Wide-field fundus photograph from neonatal ROP screening · 1440x1080px · Natus RetCam Envision, 130° FOV — 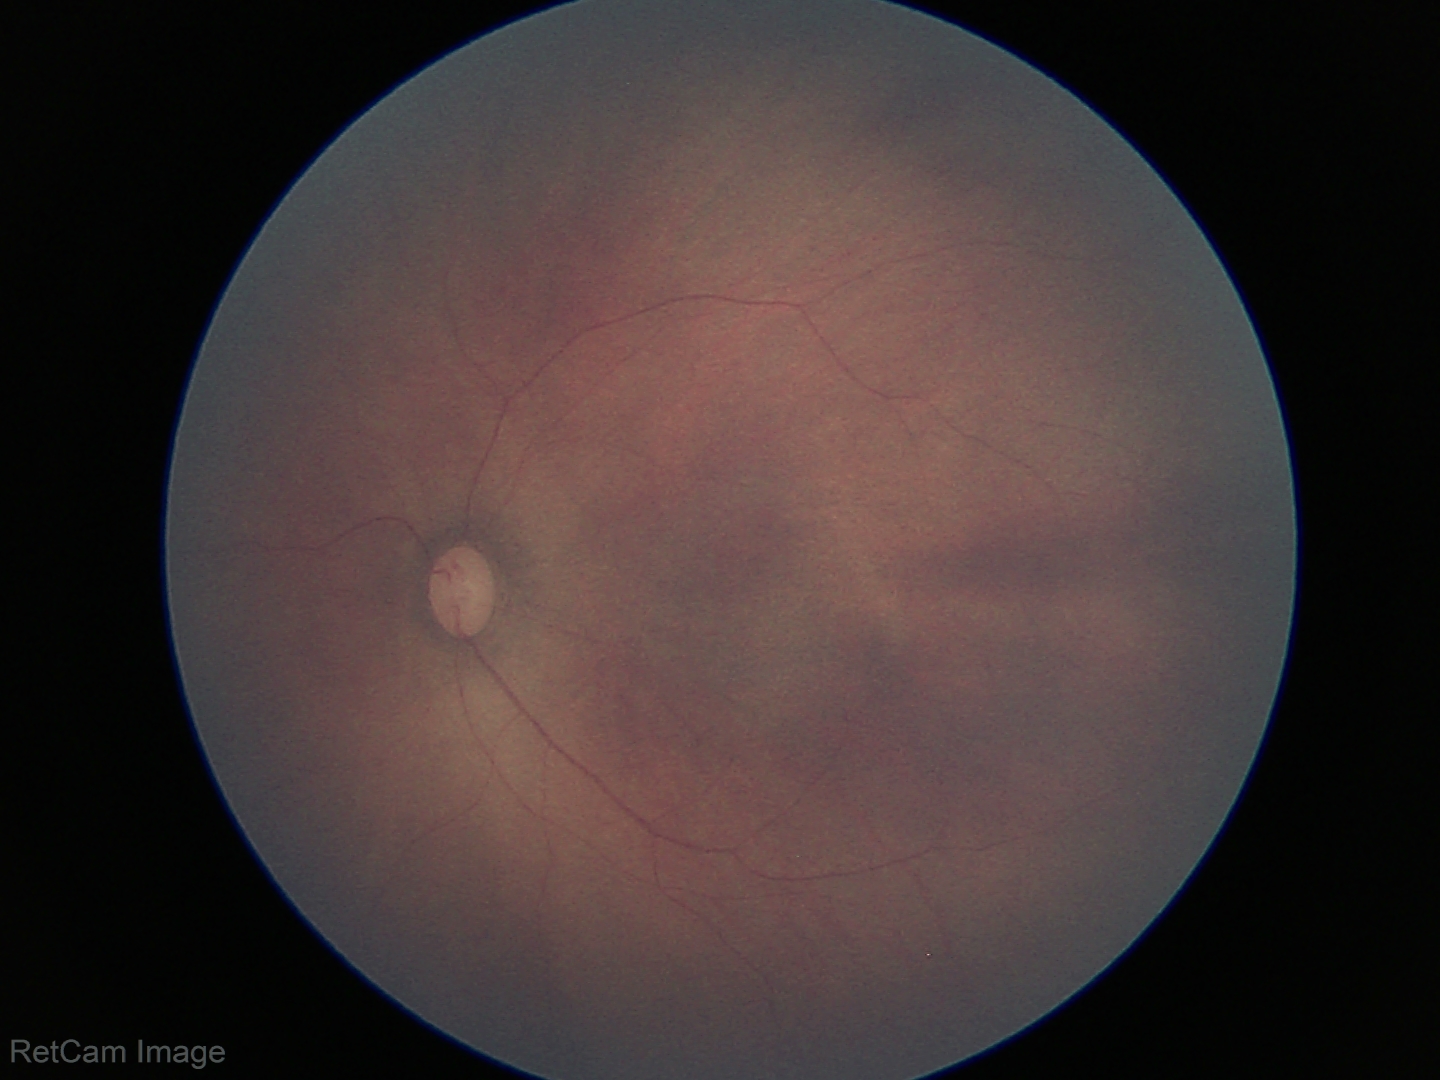

Screening examination diagnosed as physiological.